2048 by 1536 pixels. 45° FOV: 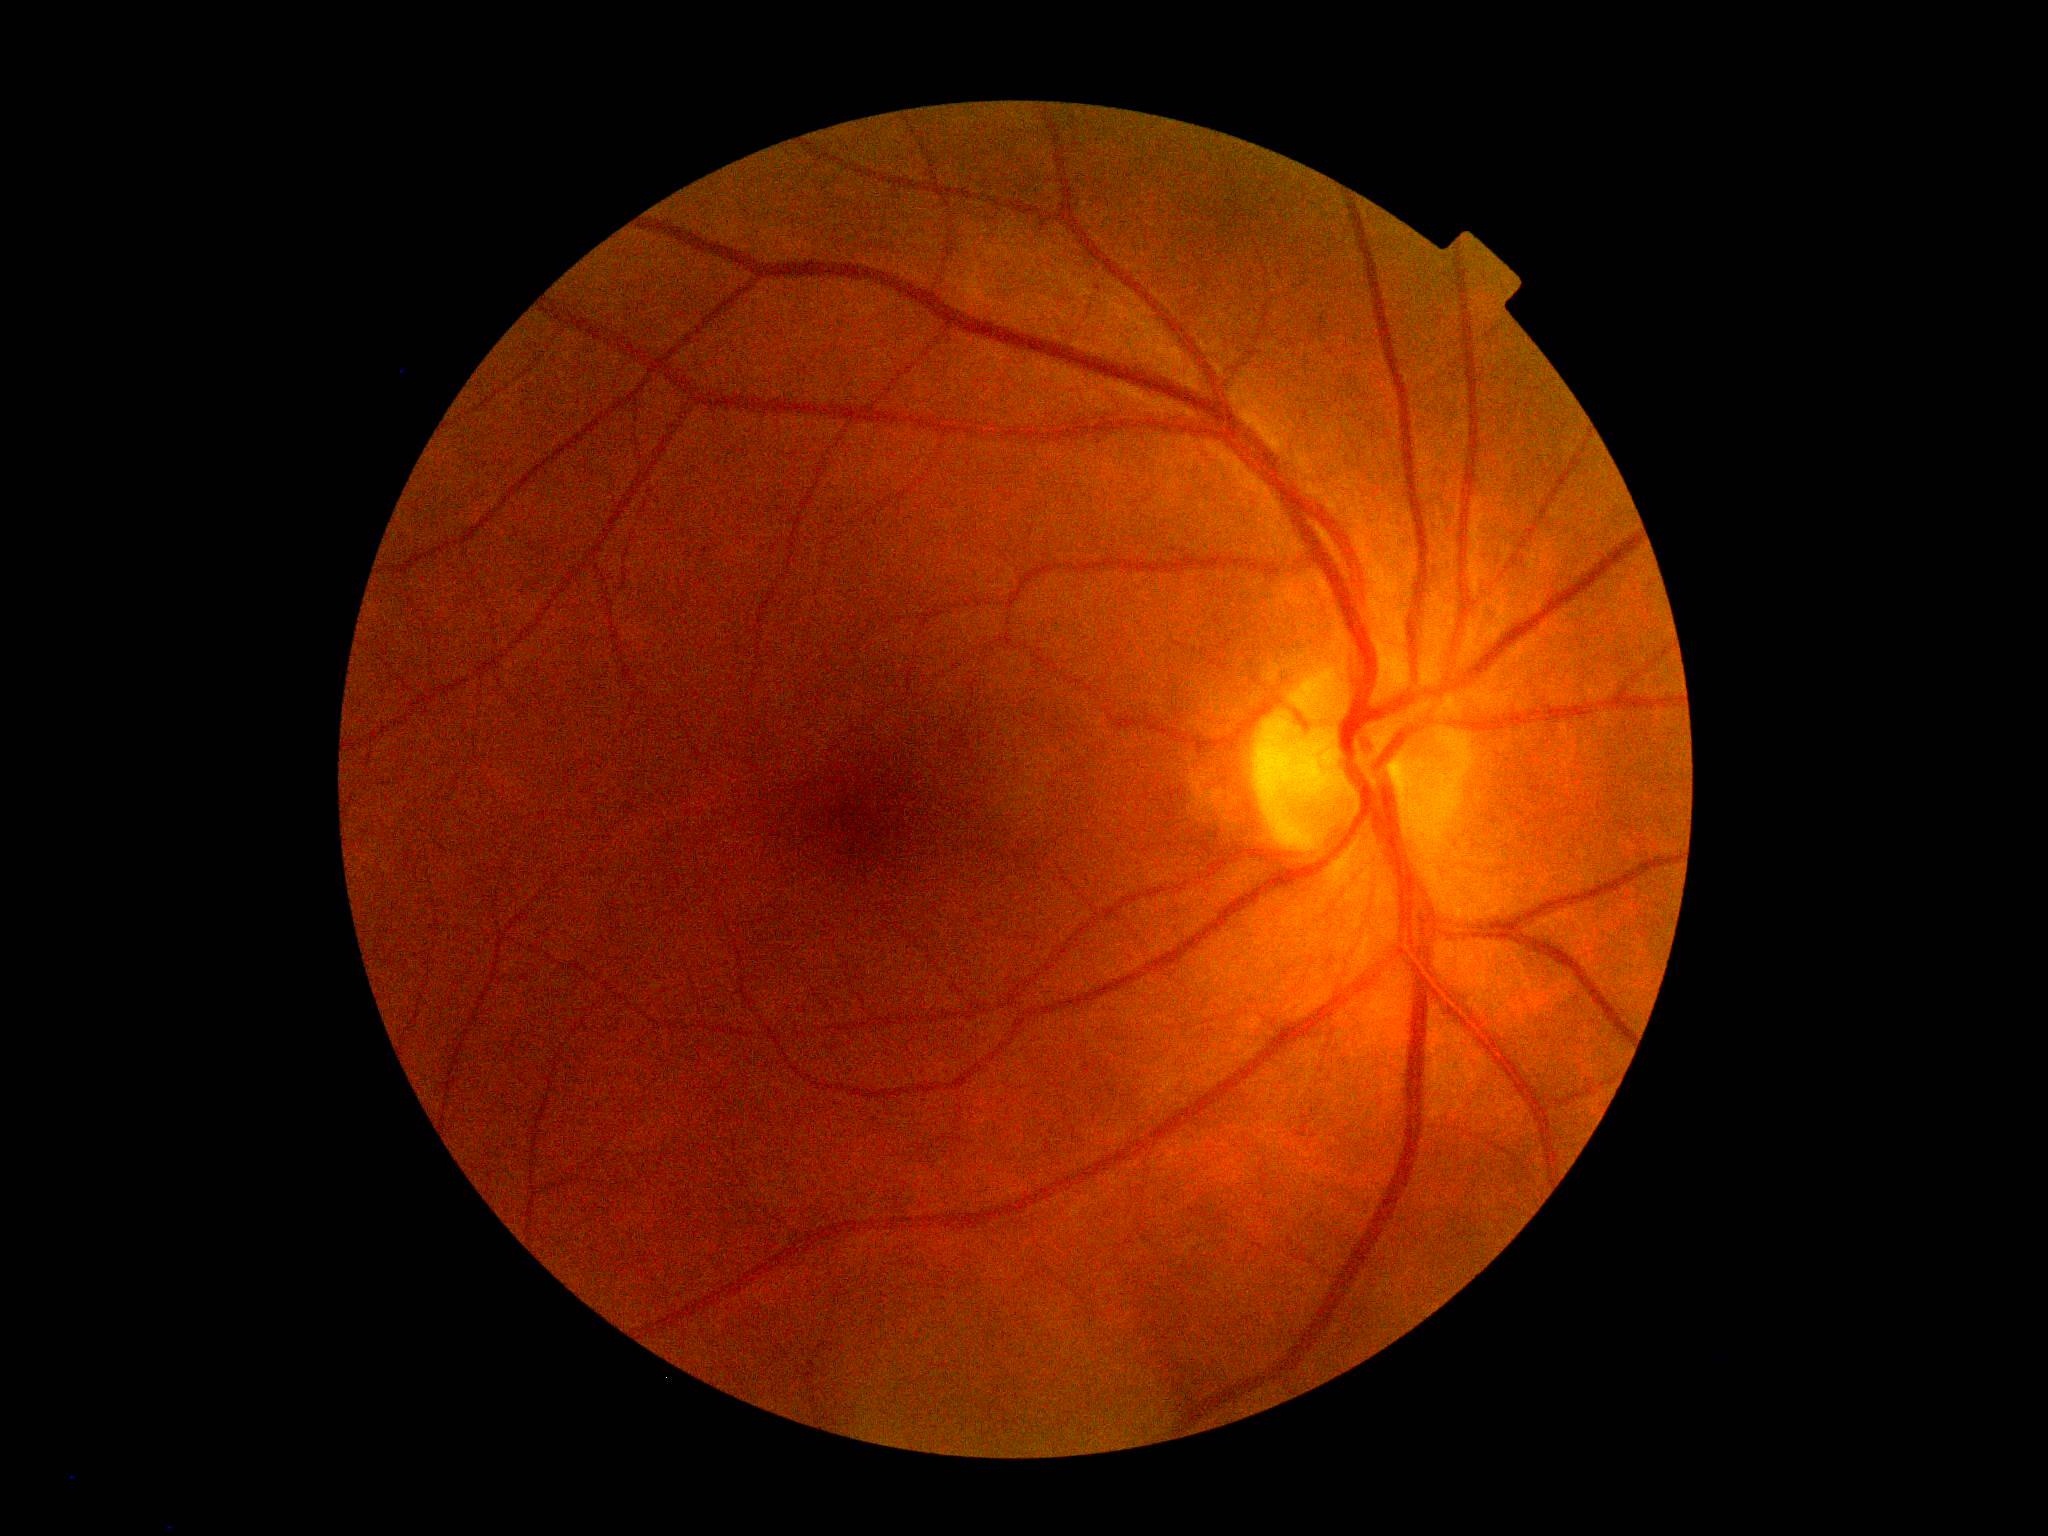 DR grade is no apparent diabetic retinopathy (0). No diabetic retinal disease findings.